NIDEK AFC-230 fundus camera, 848x848, without pupil dilation: 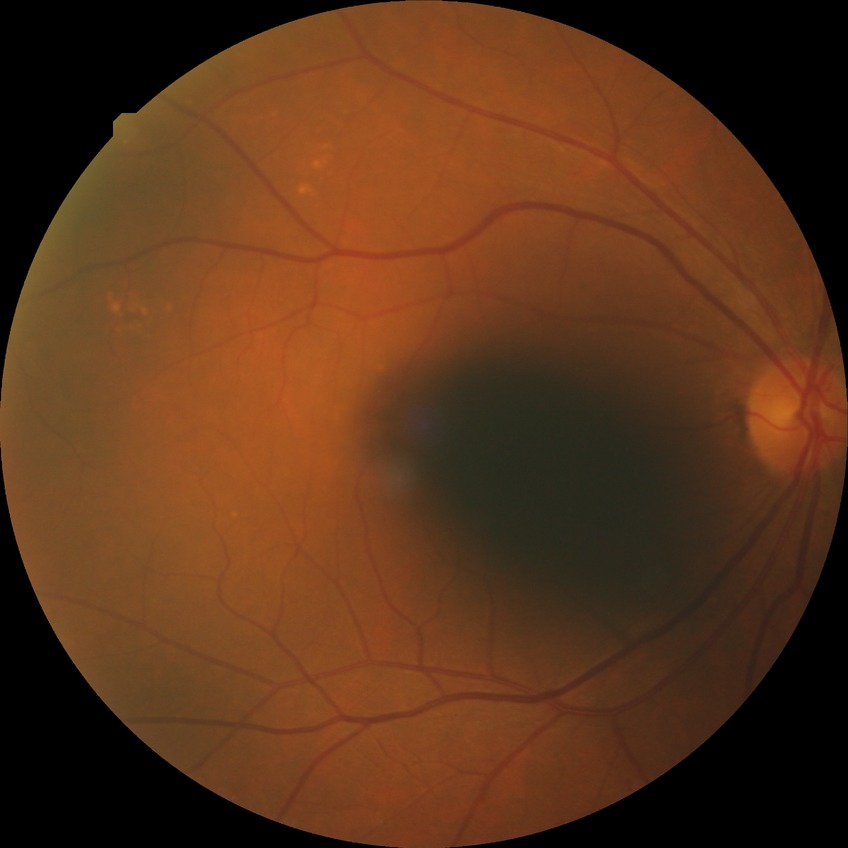 Diabetic retinopathy (DR) is no diabetic retinopathy (NDR).